Color fundus photograph.
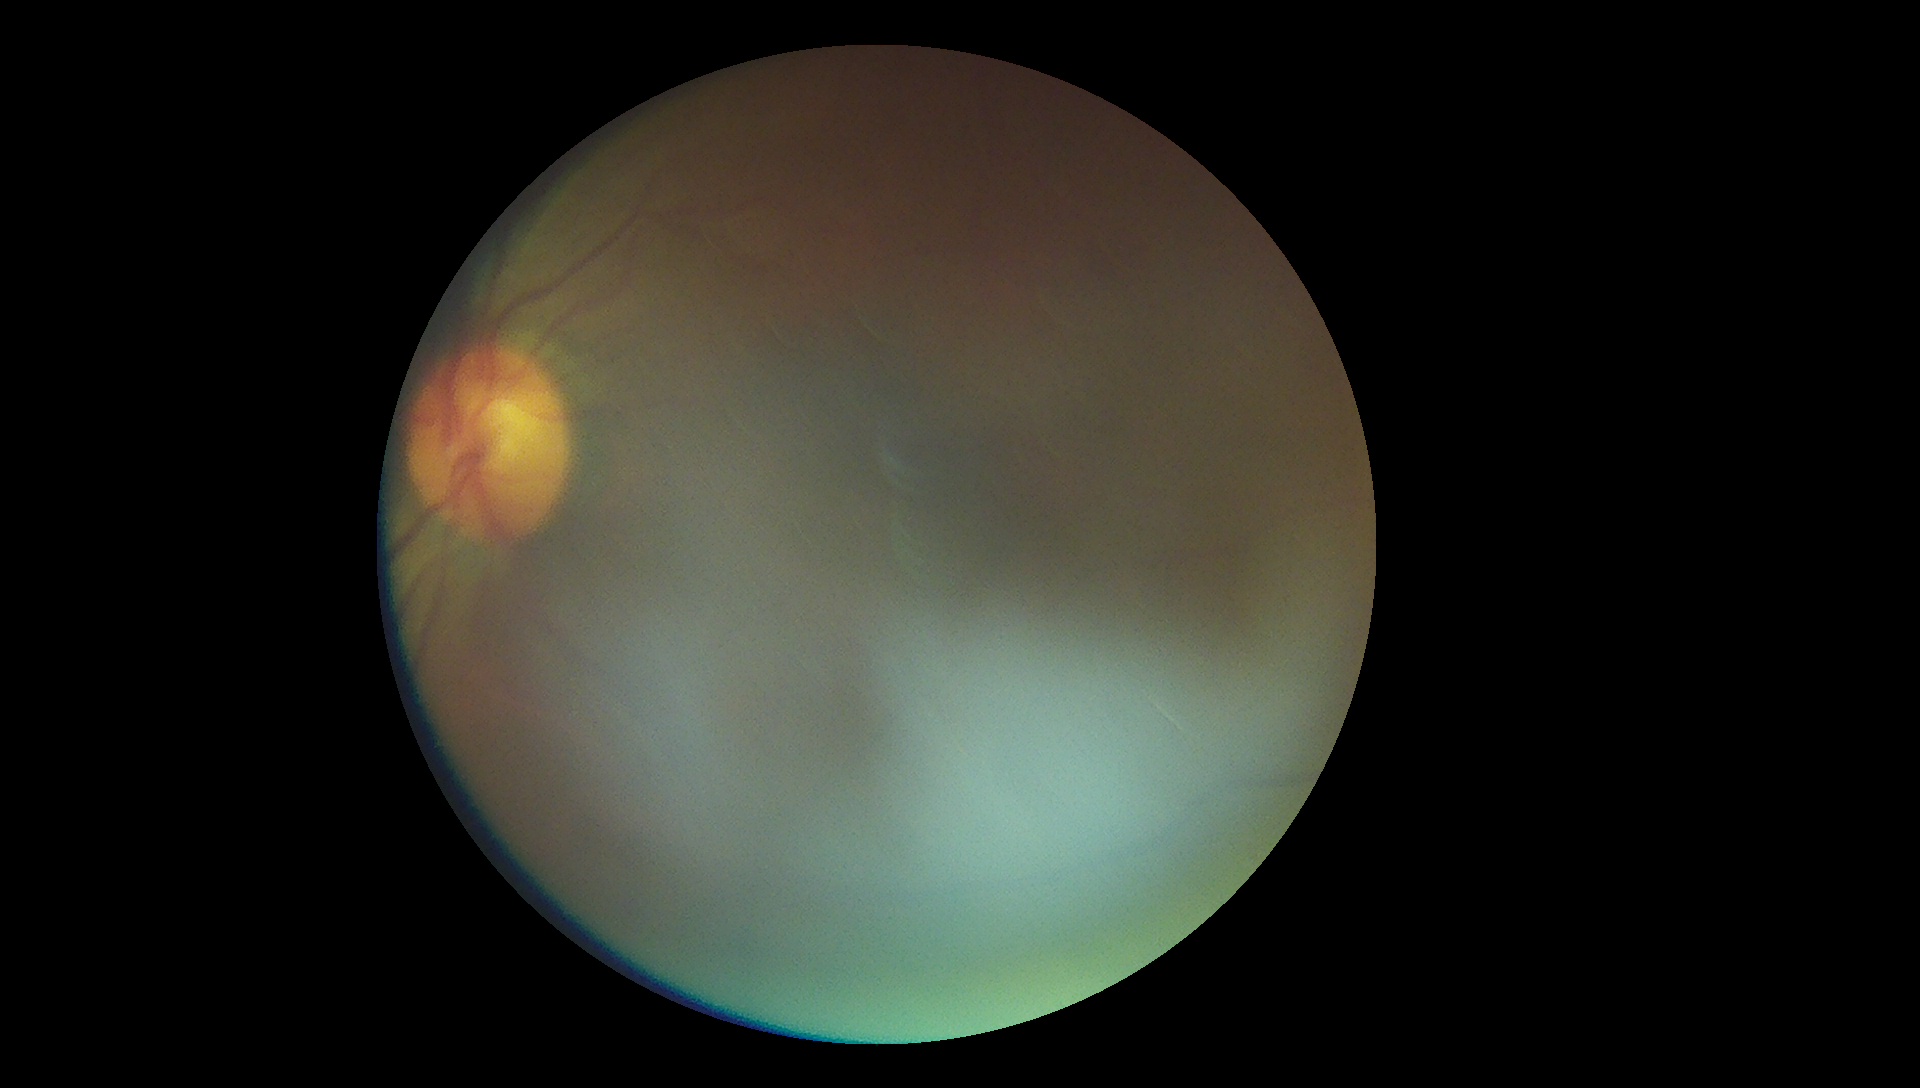 Quality too poor to assess for DR. Diabetic retinopathy severity: ungradable due to poor image quality.